Image size 2048x1536.
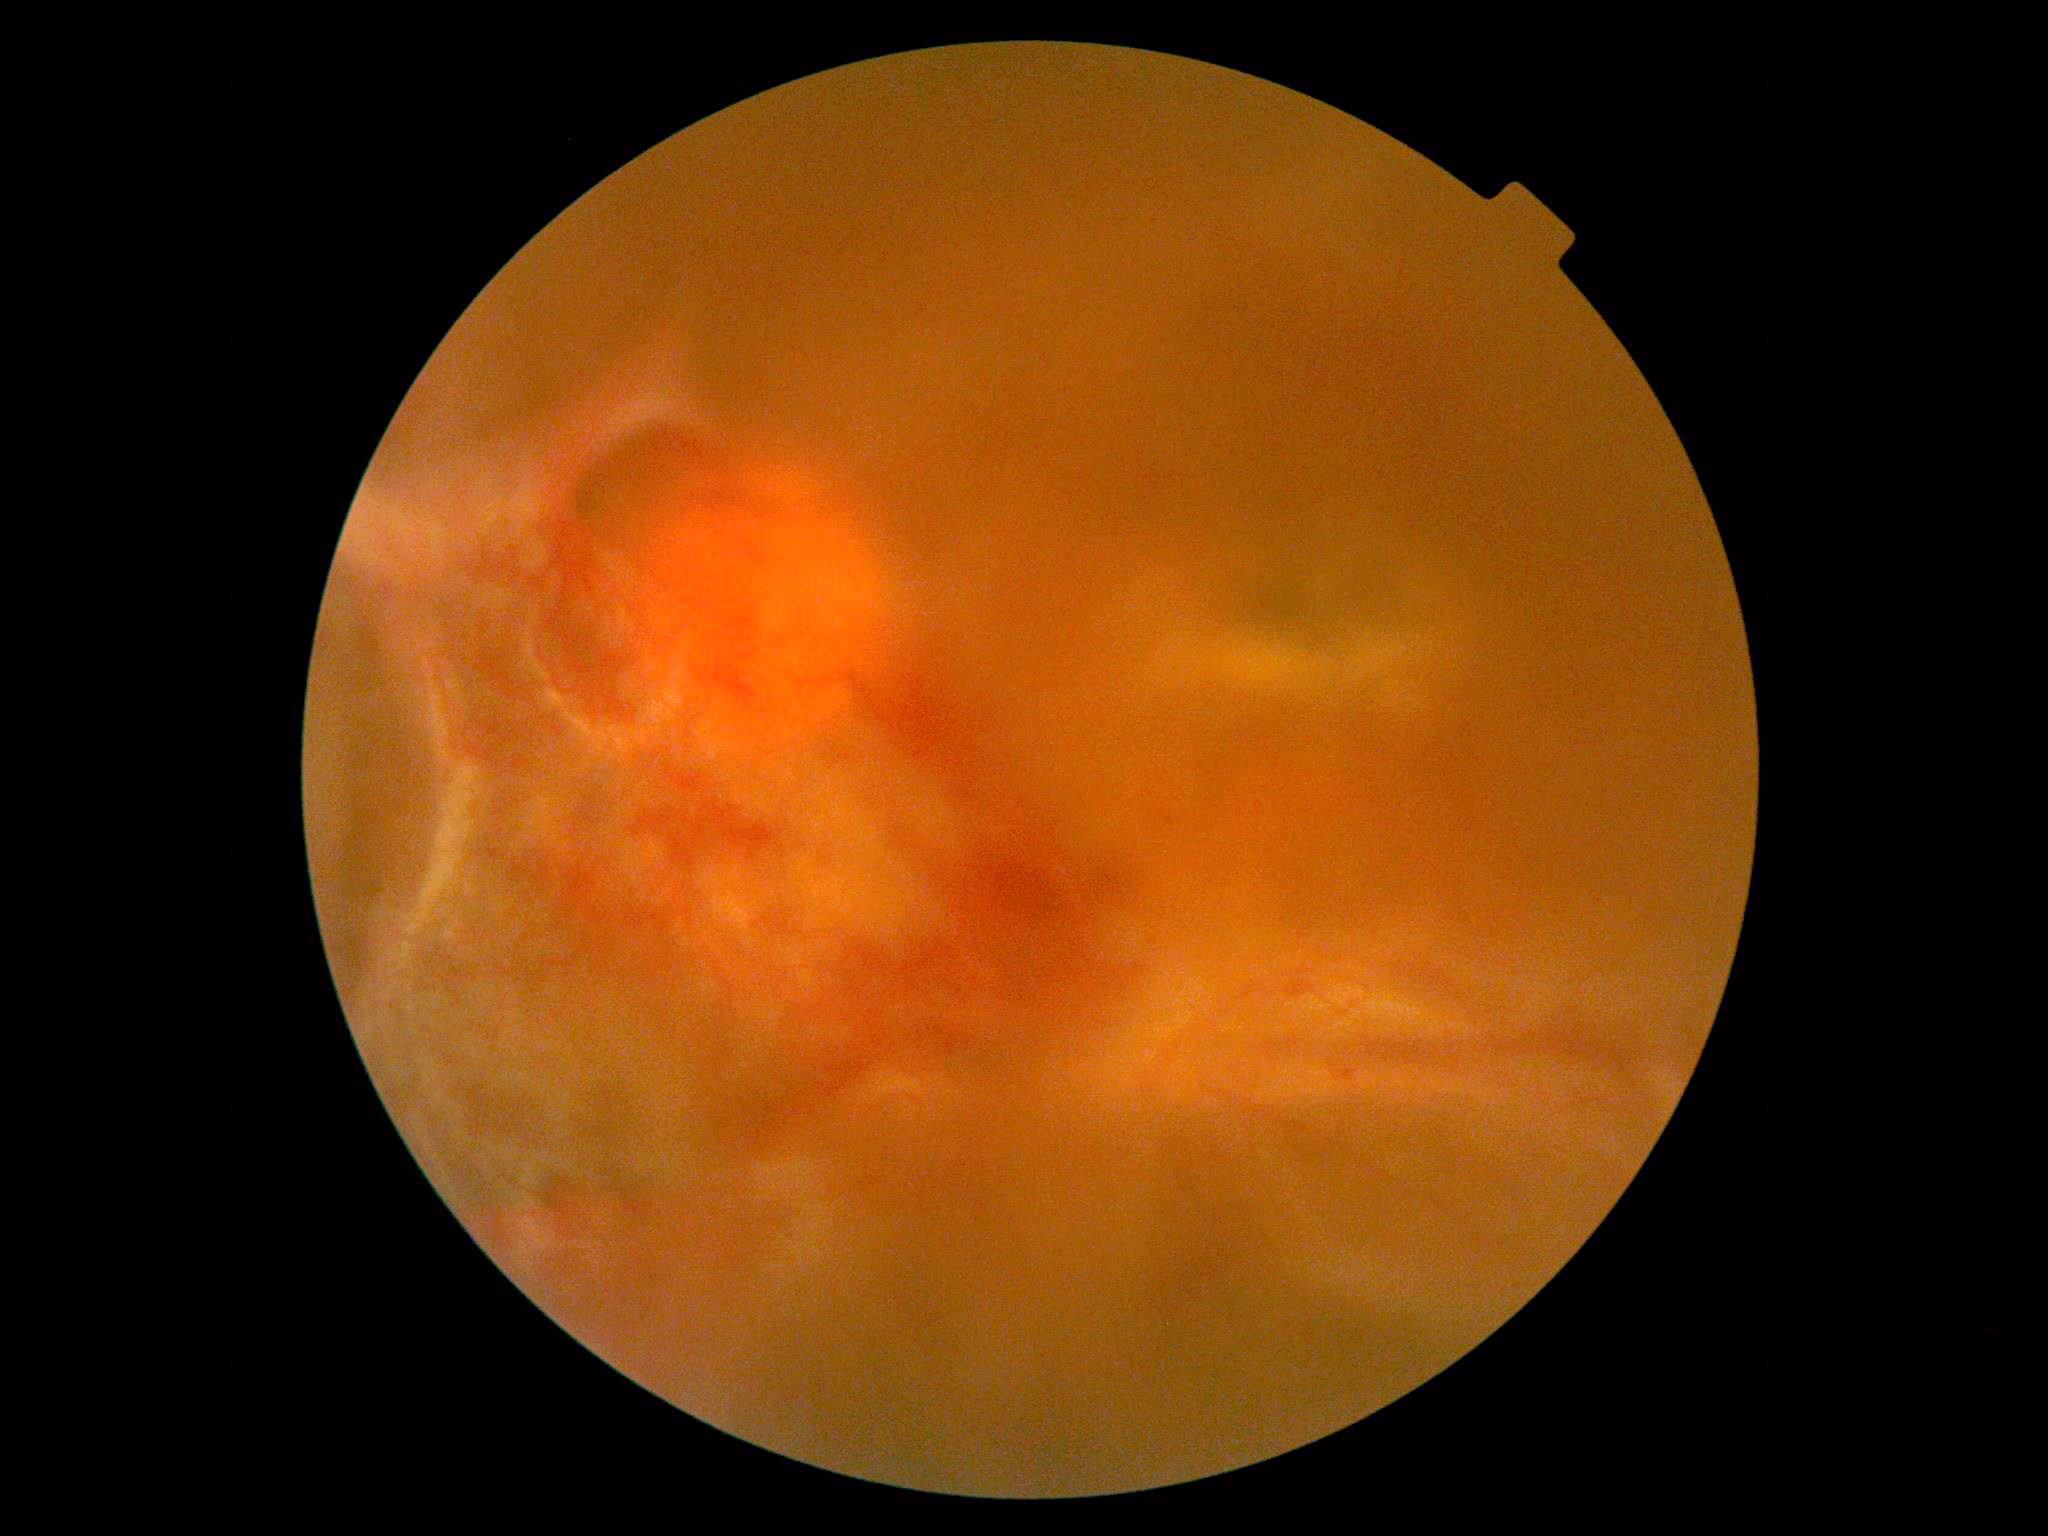

Diabetic retinopathy grade is 4/4. DR class: proliferative diabetic retinopathy.